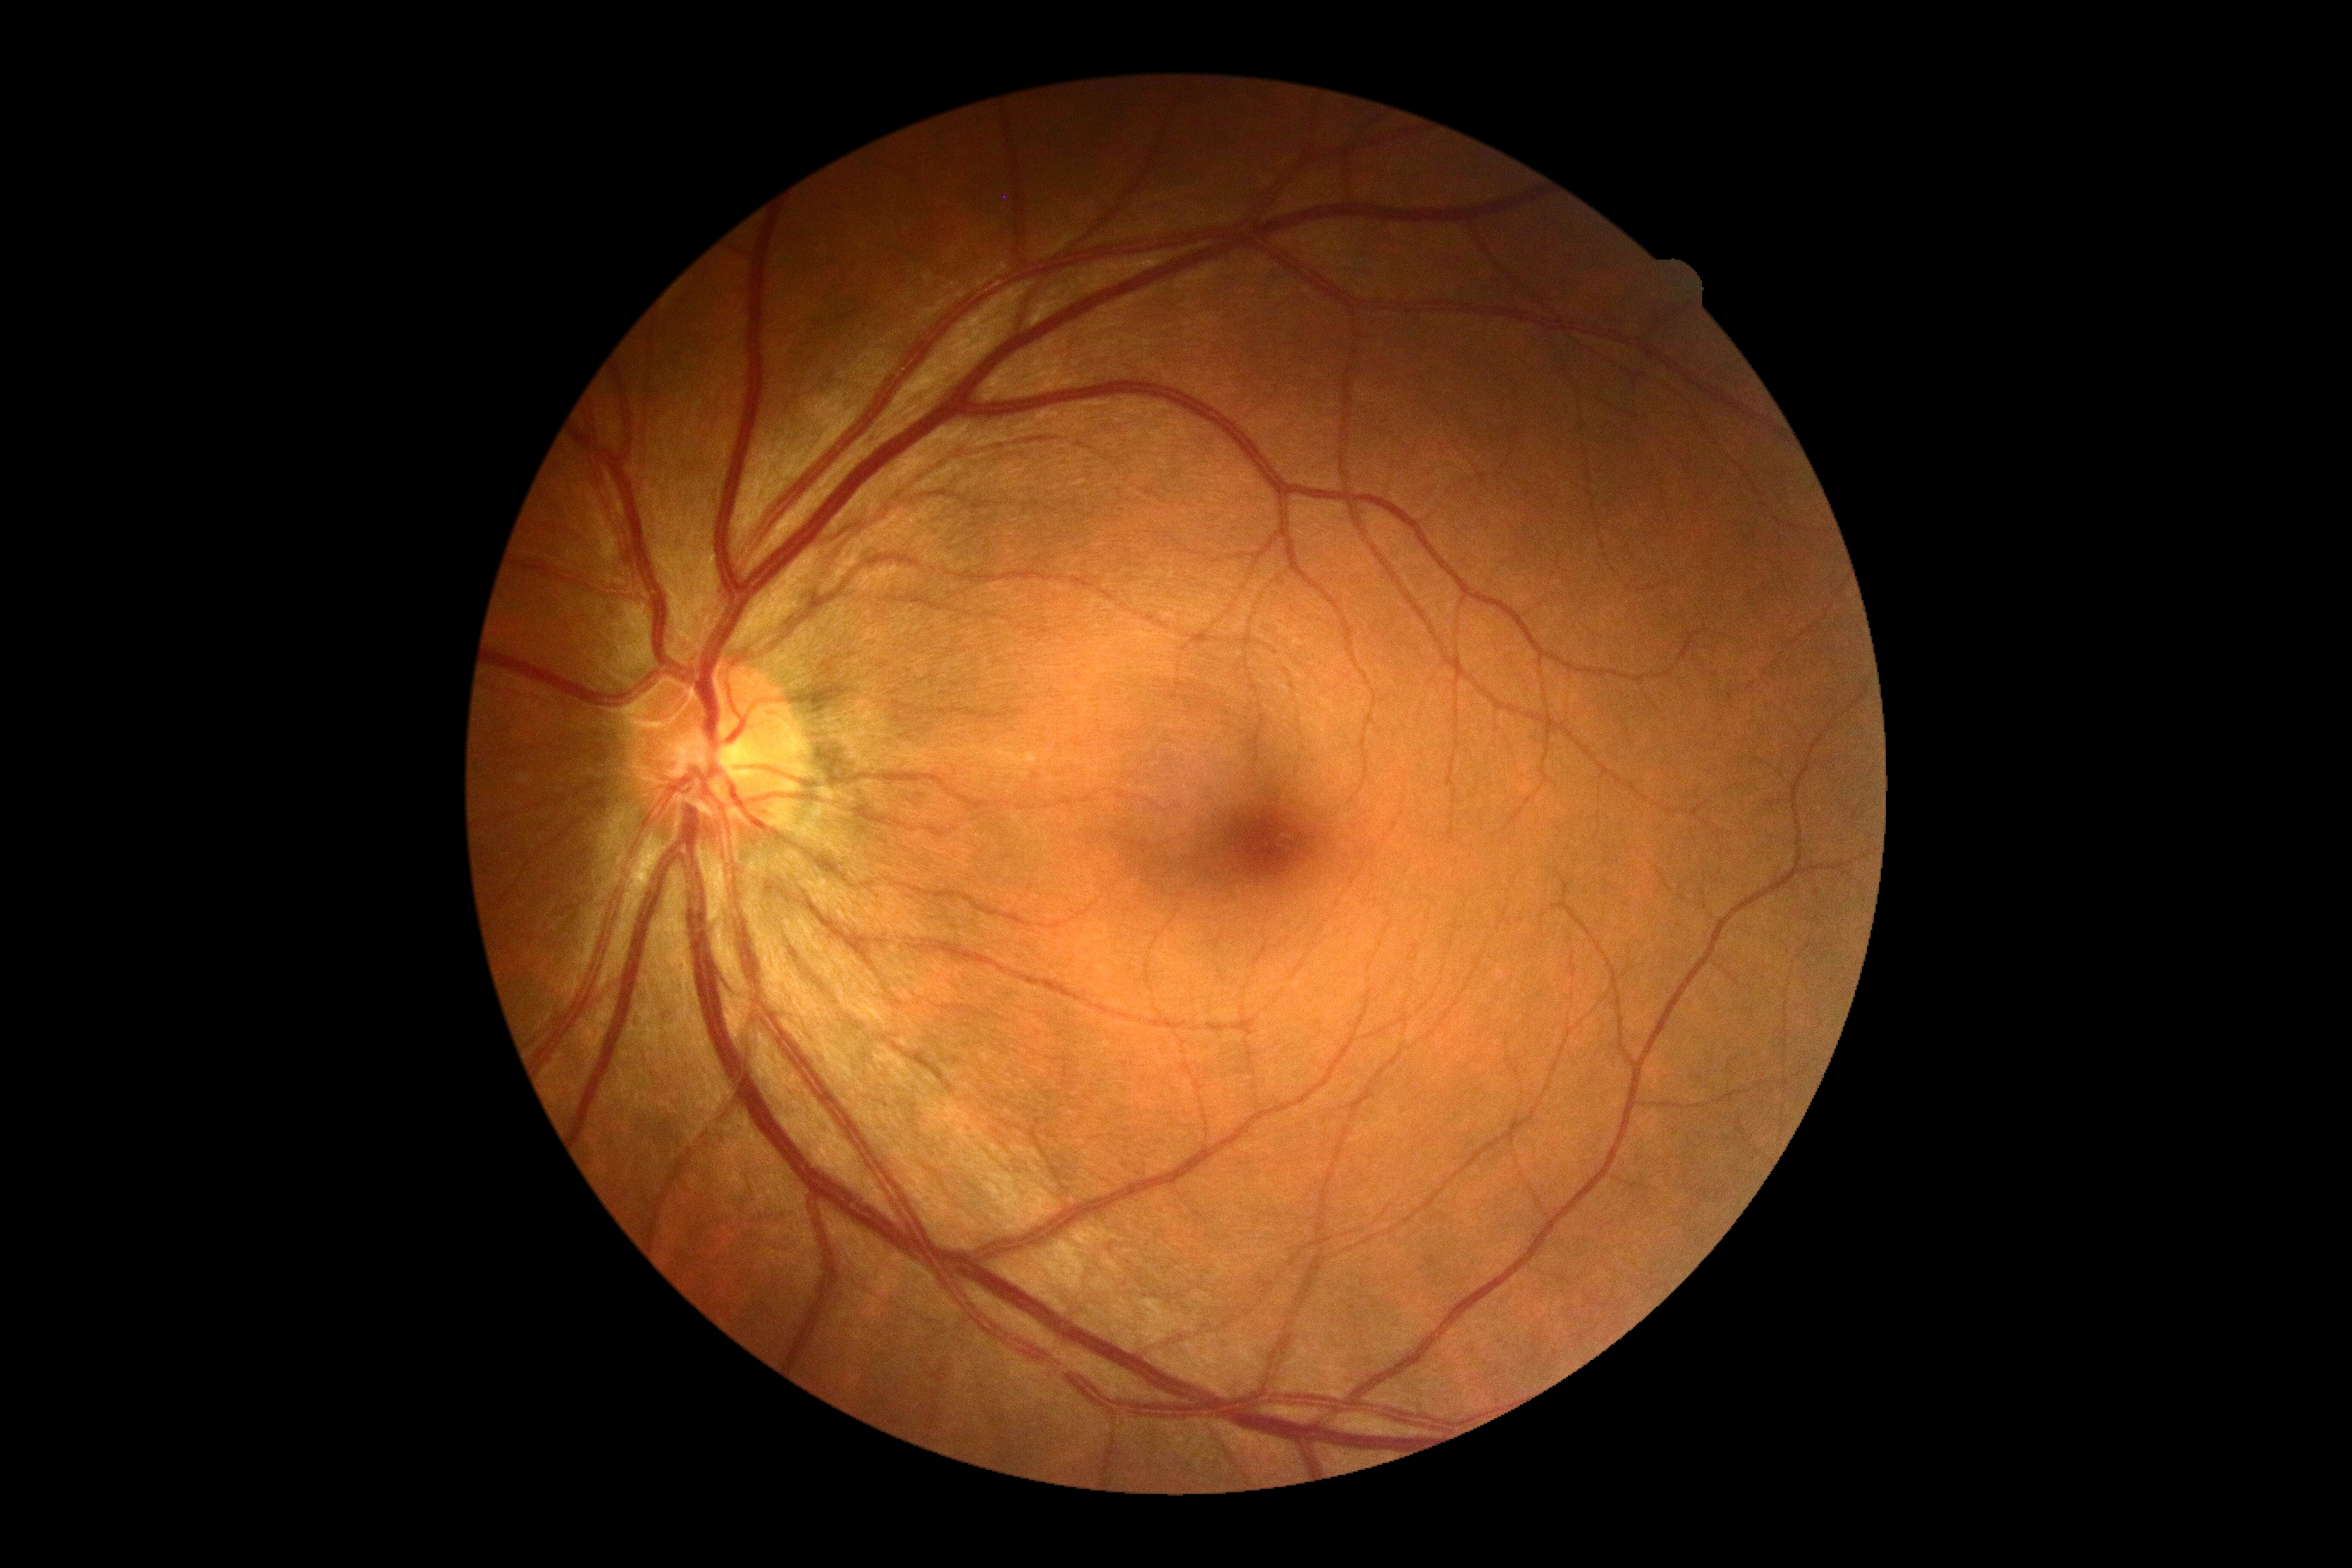
dr_grade: 0 (no apparent retinopathy)